Image size 2212x1659 · FOV: 45 degrees — 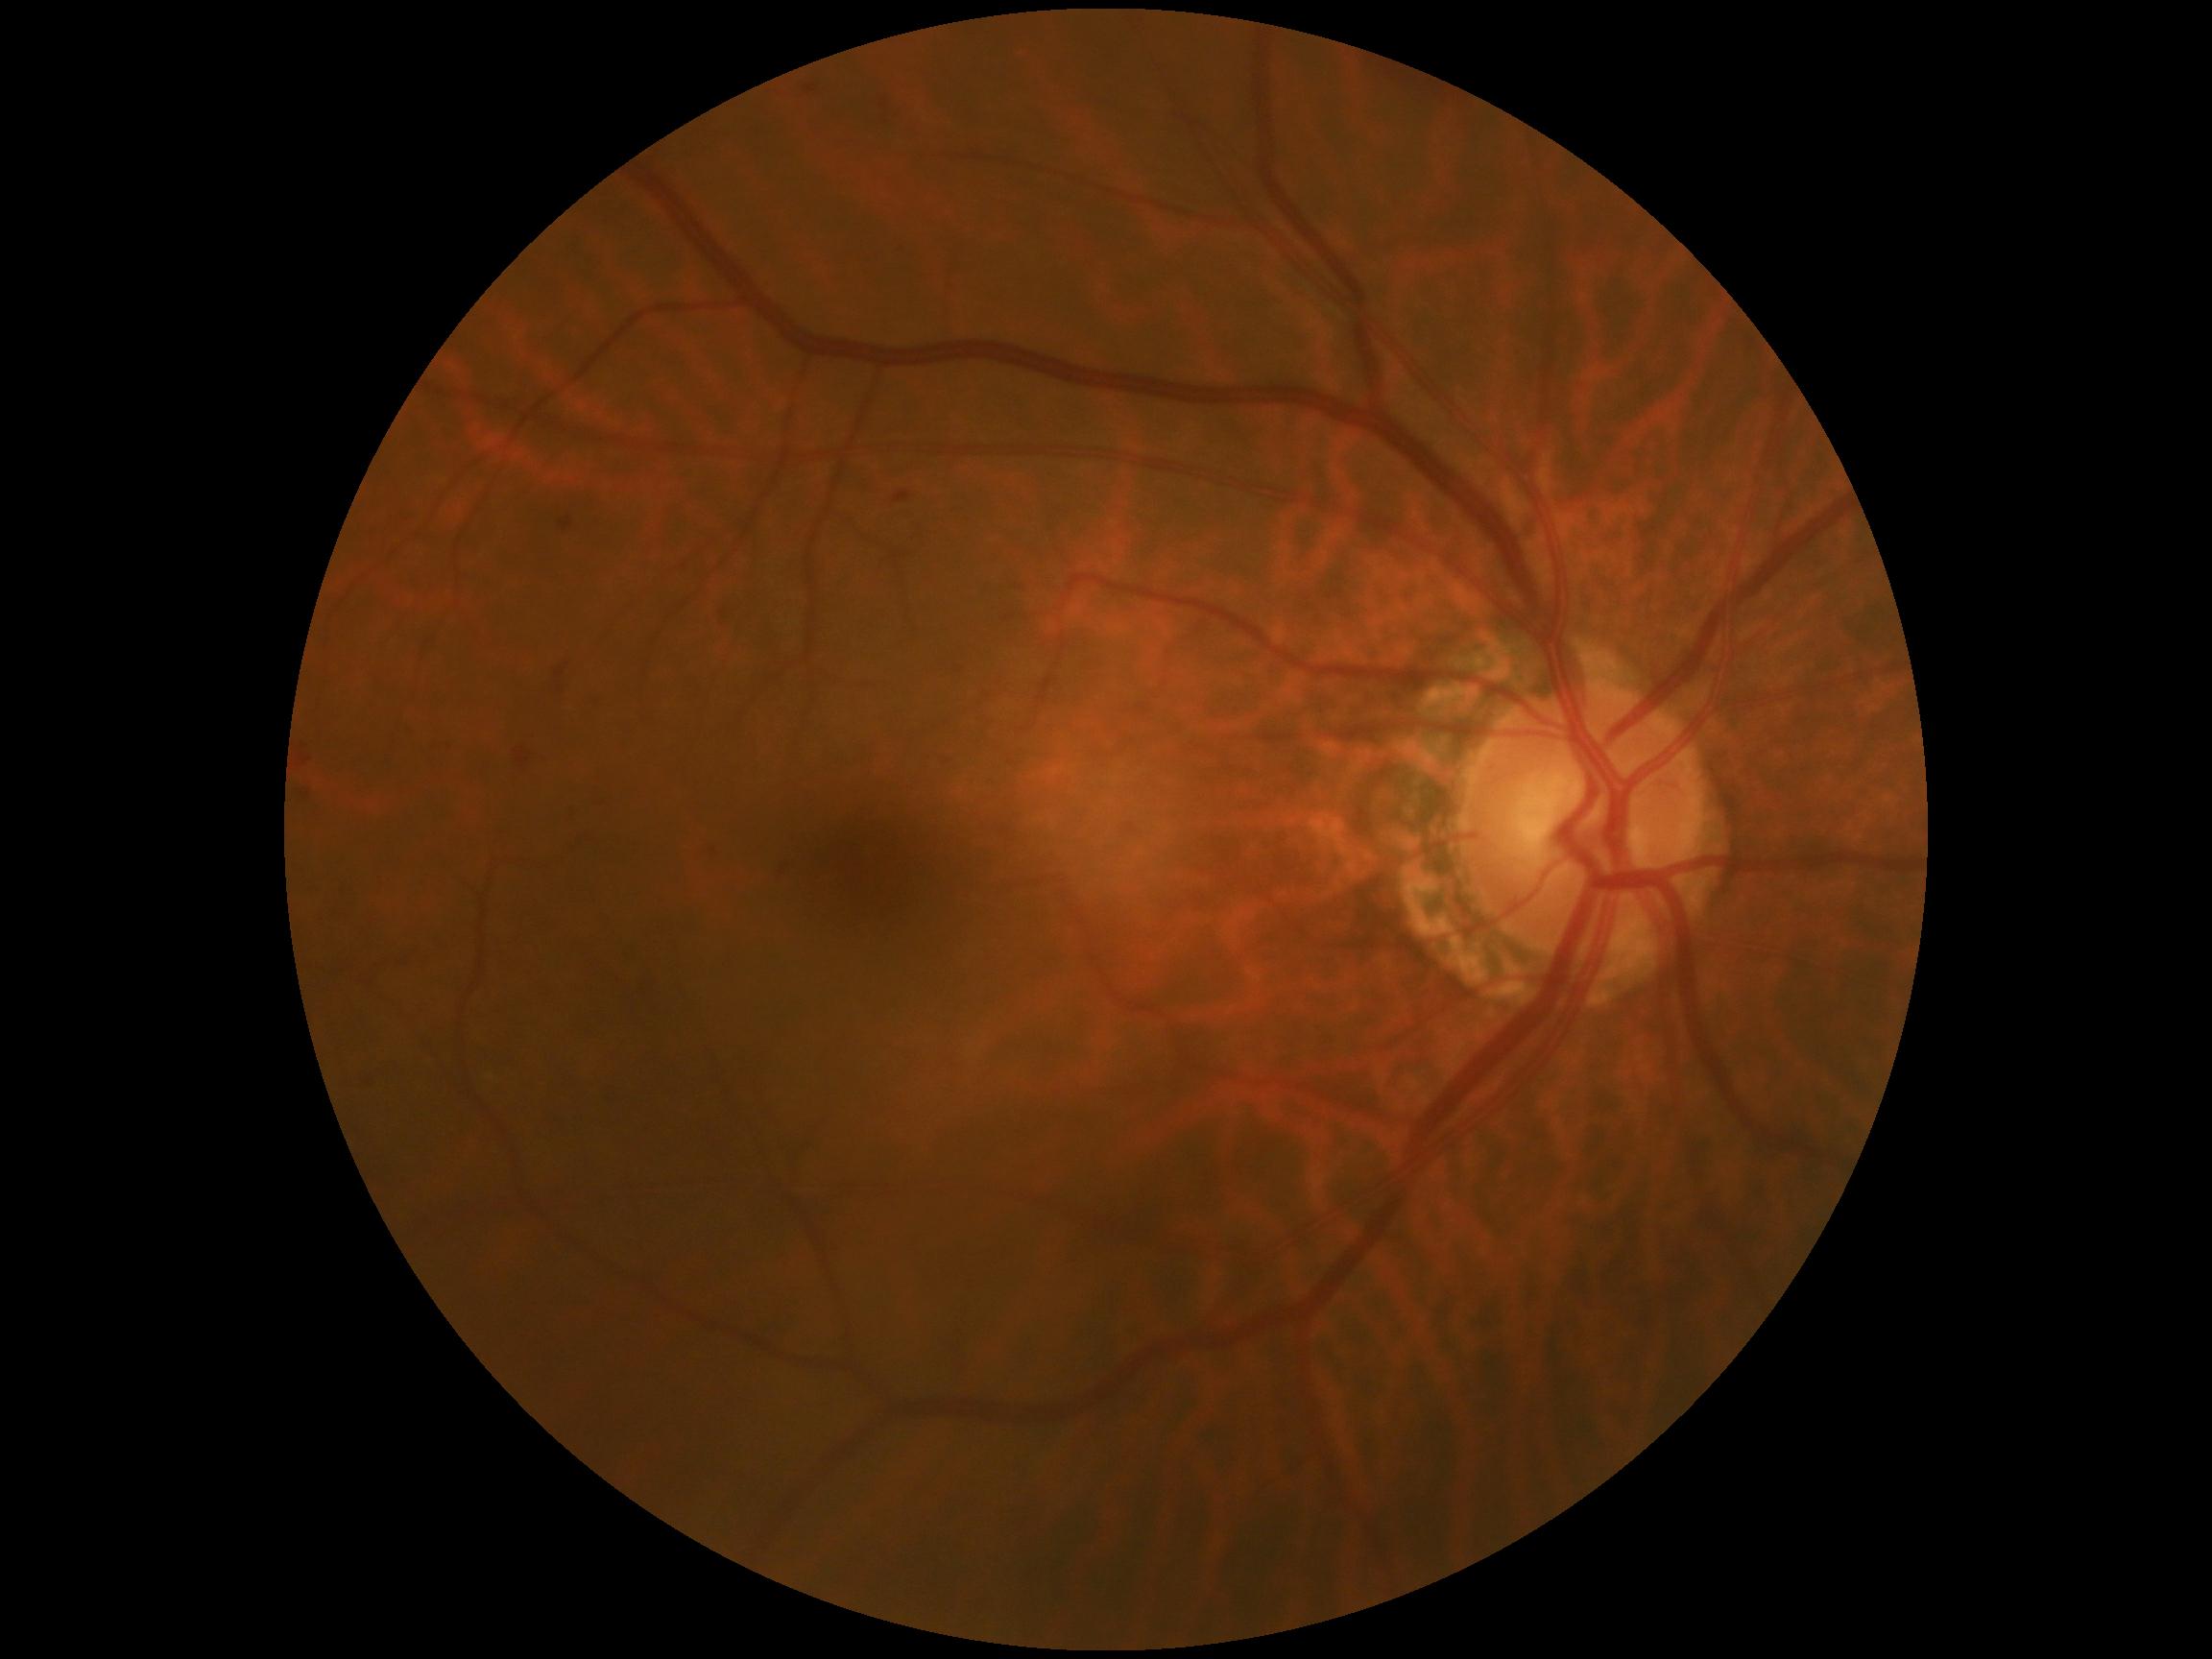

The retinopathy is classified as non-proliferative diabetic retinopathy. Diabetic retinopathy severity is 2 — more than just microaneurysms but less than severe NPDR.